Pediatric retinal photograph (wide-field); 640 by 480 pixels: 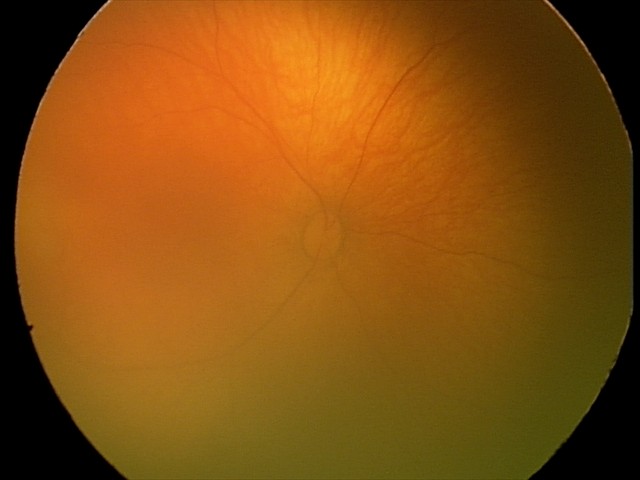
No retinal pathology identified on screening.